1659x2212; color fundus photograph.
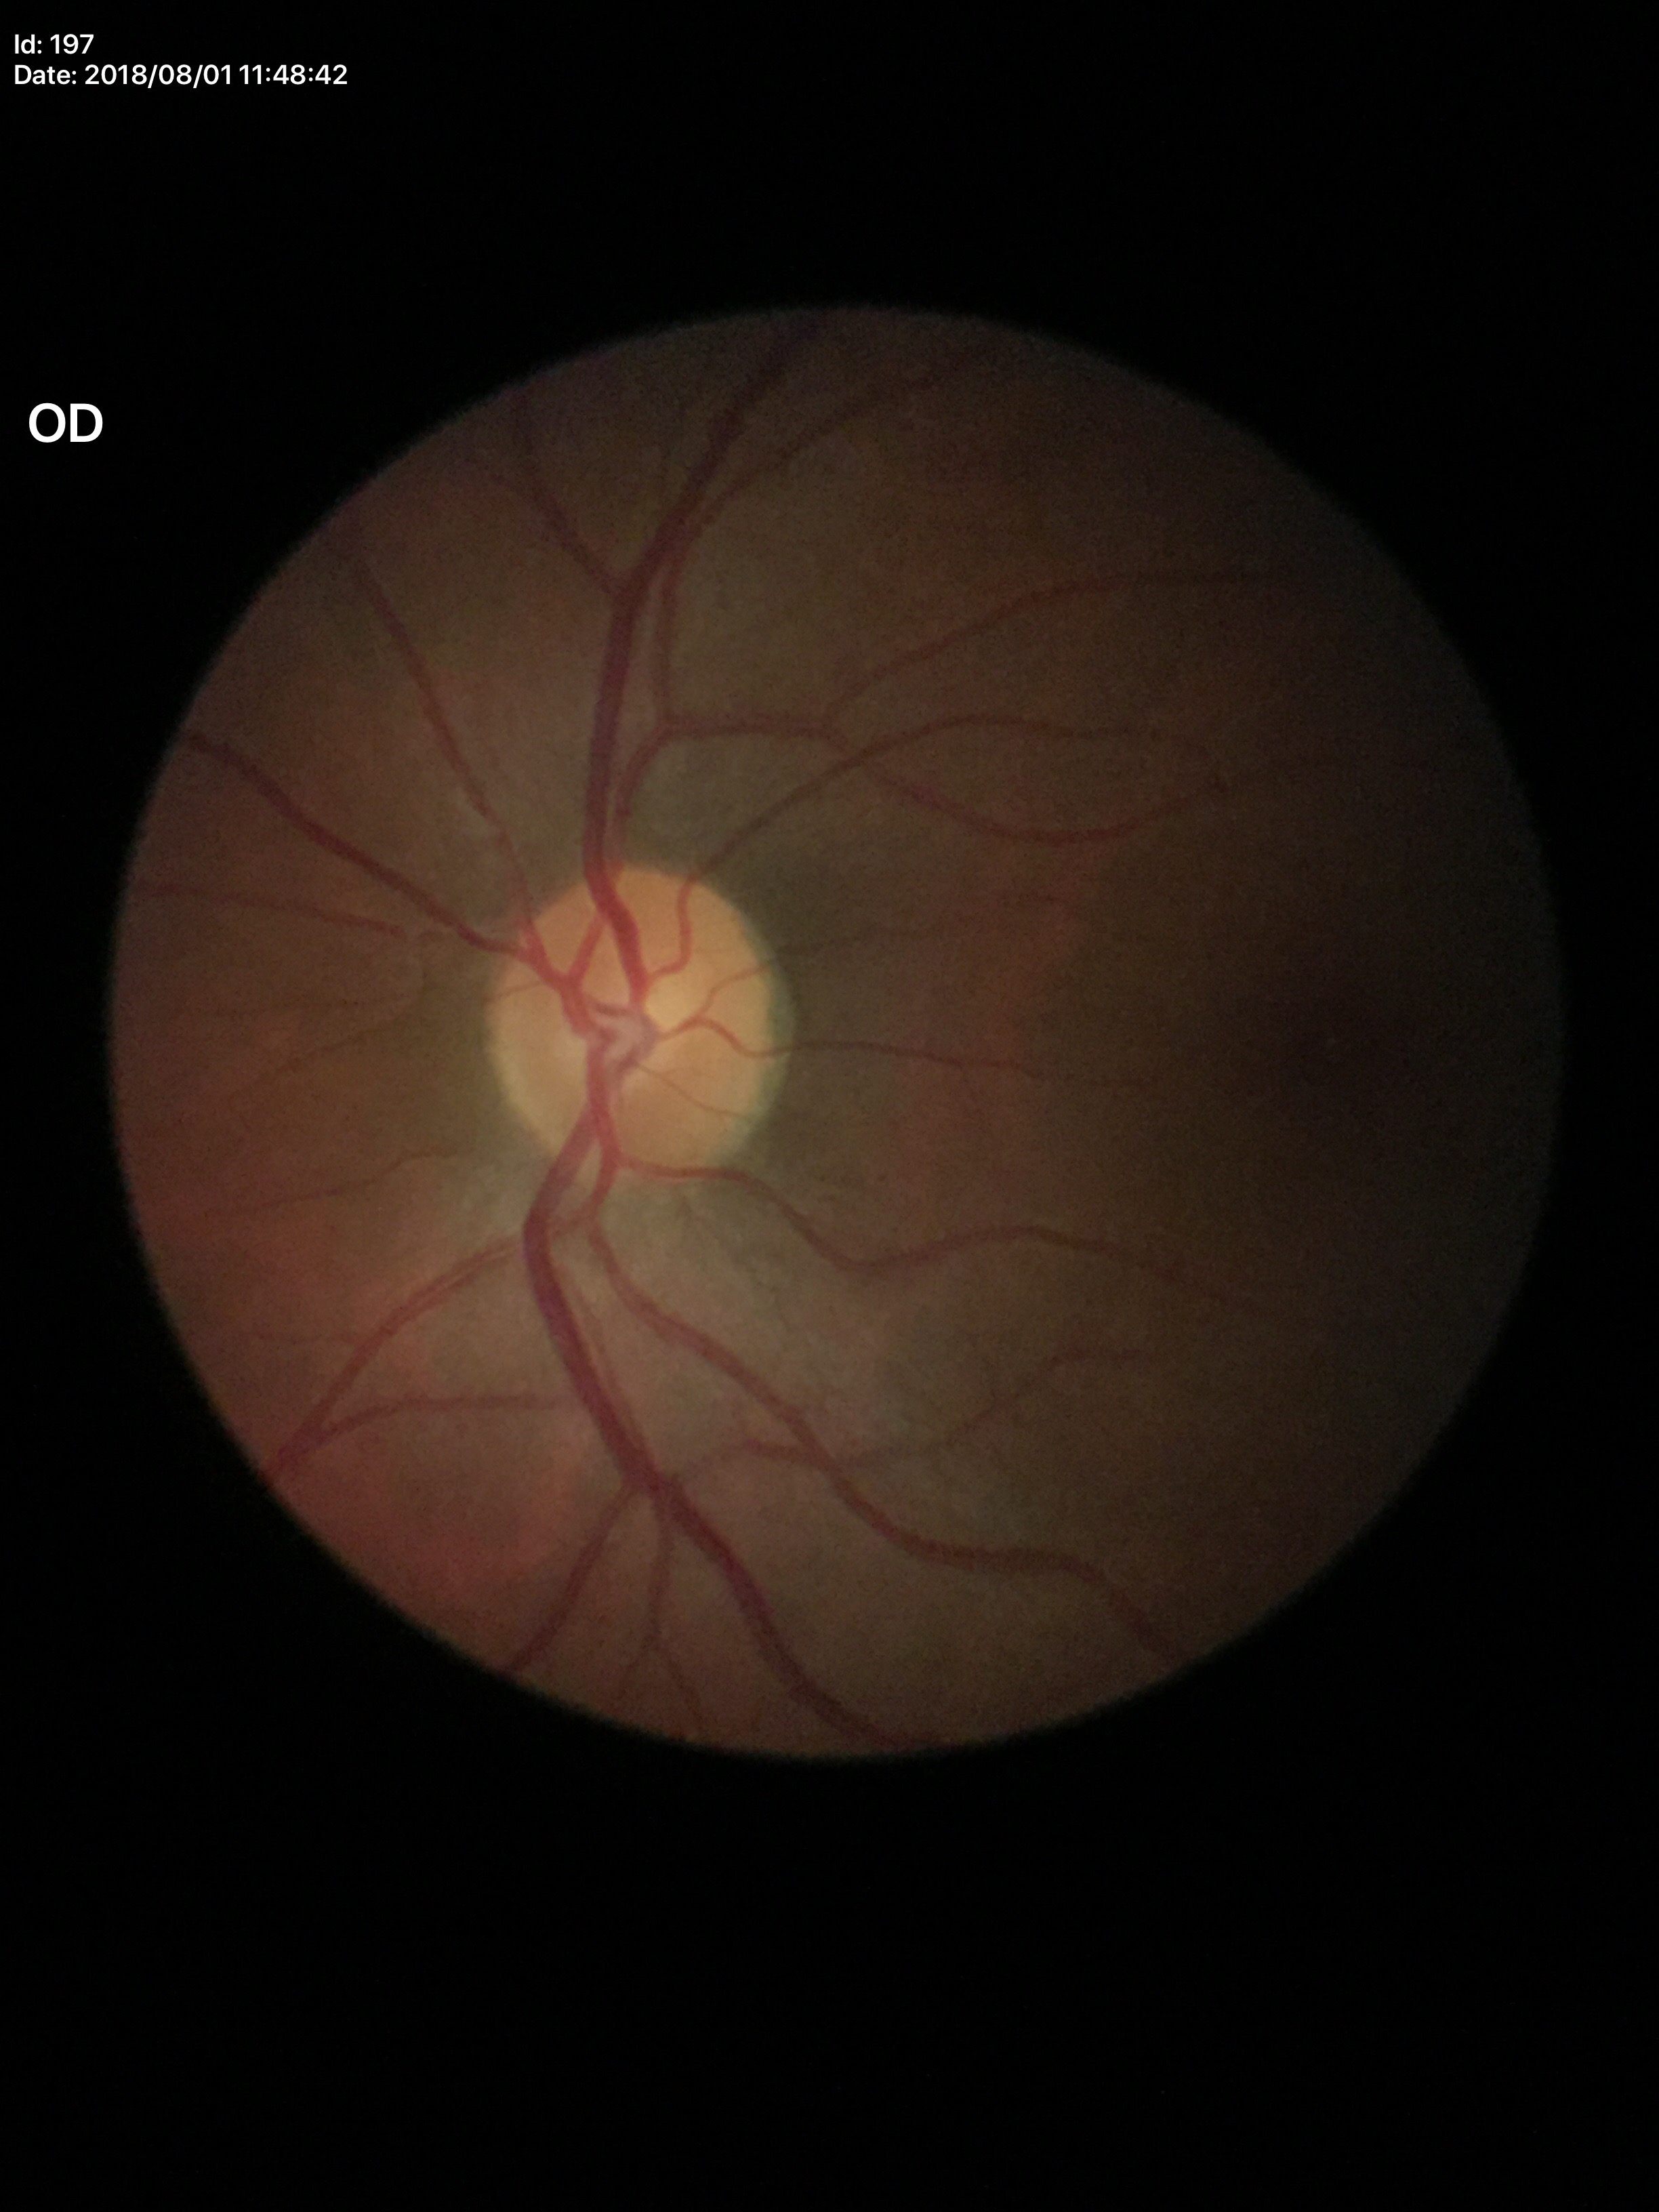
vertical C/D ratio (VCDR): 0.48; area cup-to-disc ratio (ACDR): 0.25; Glaucoma evaluation: no suspicious findings